45-degree field of view · image size 1932x1932
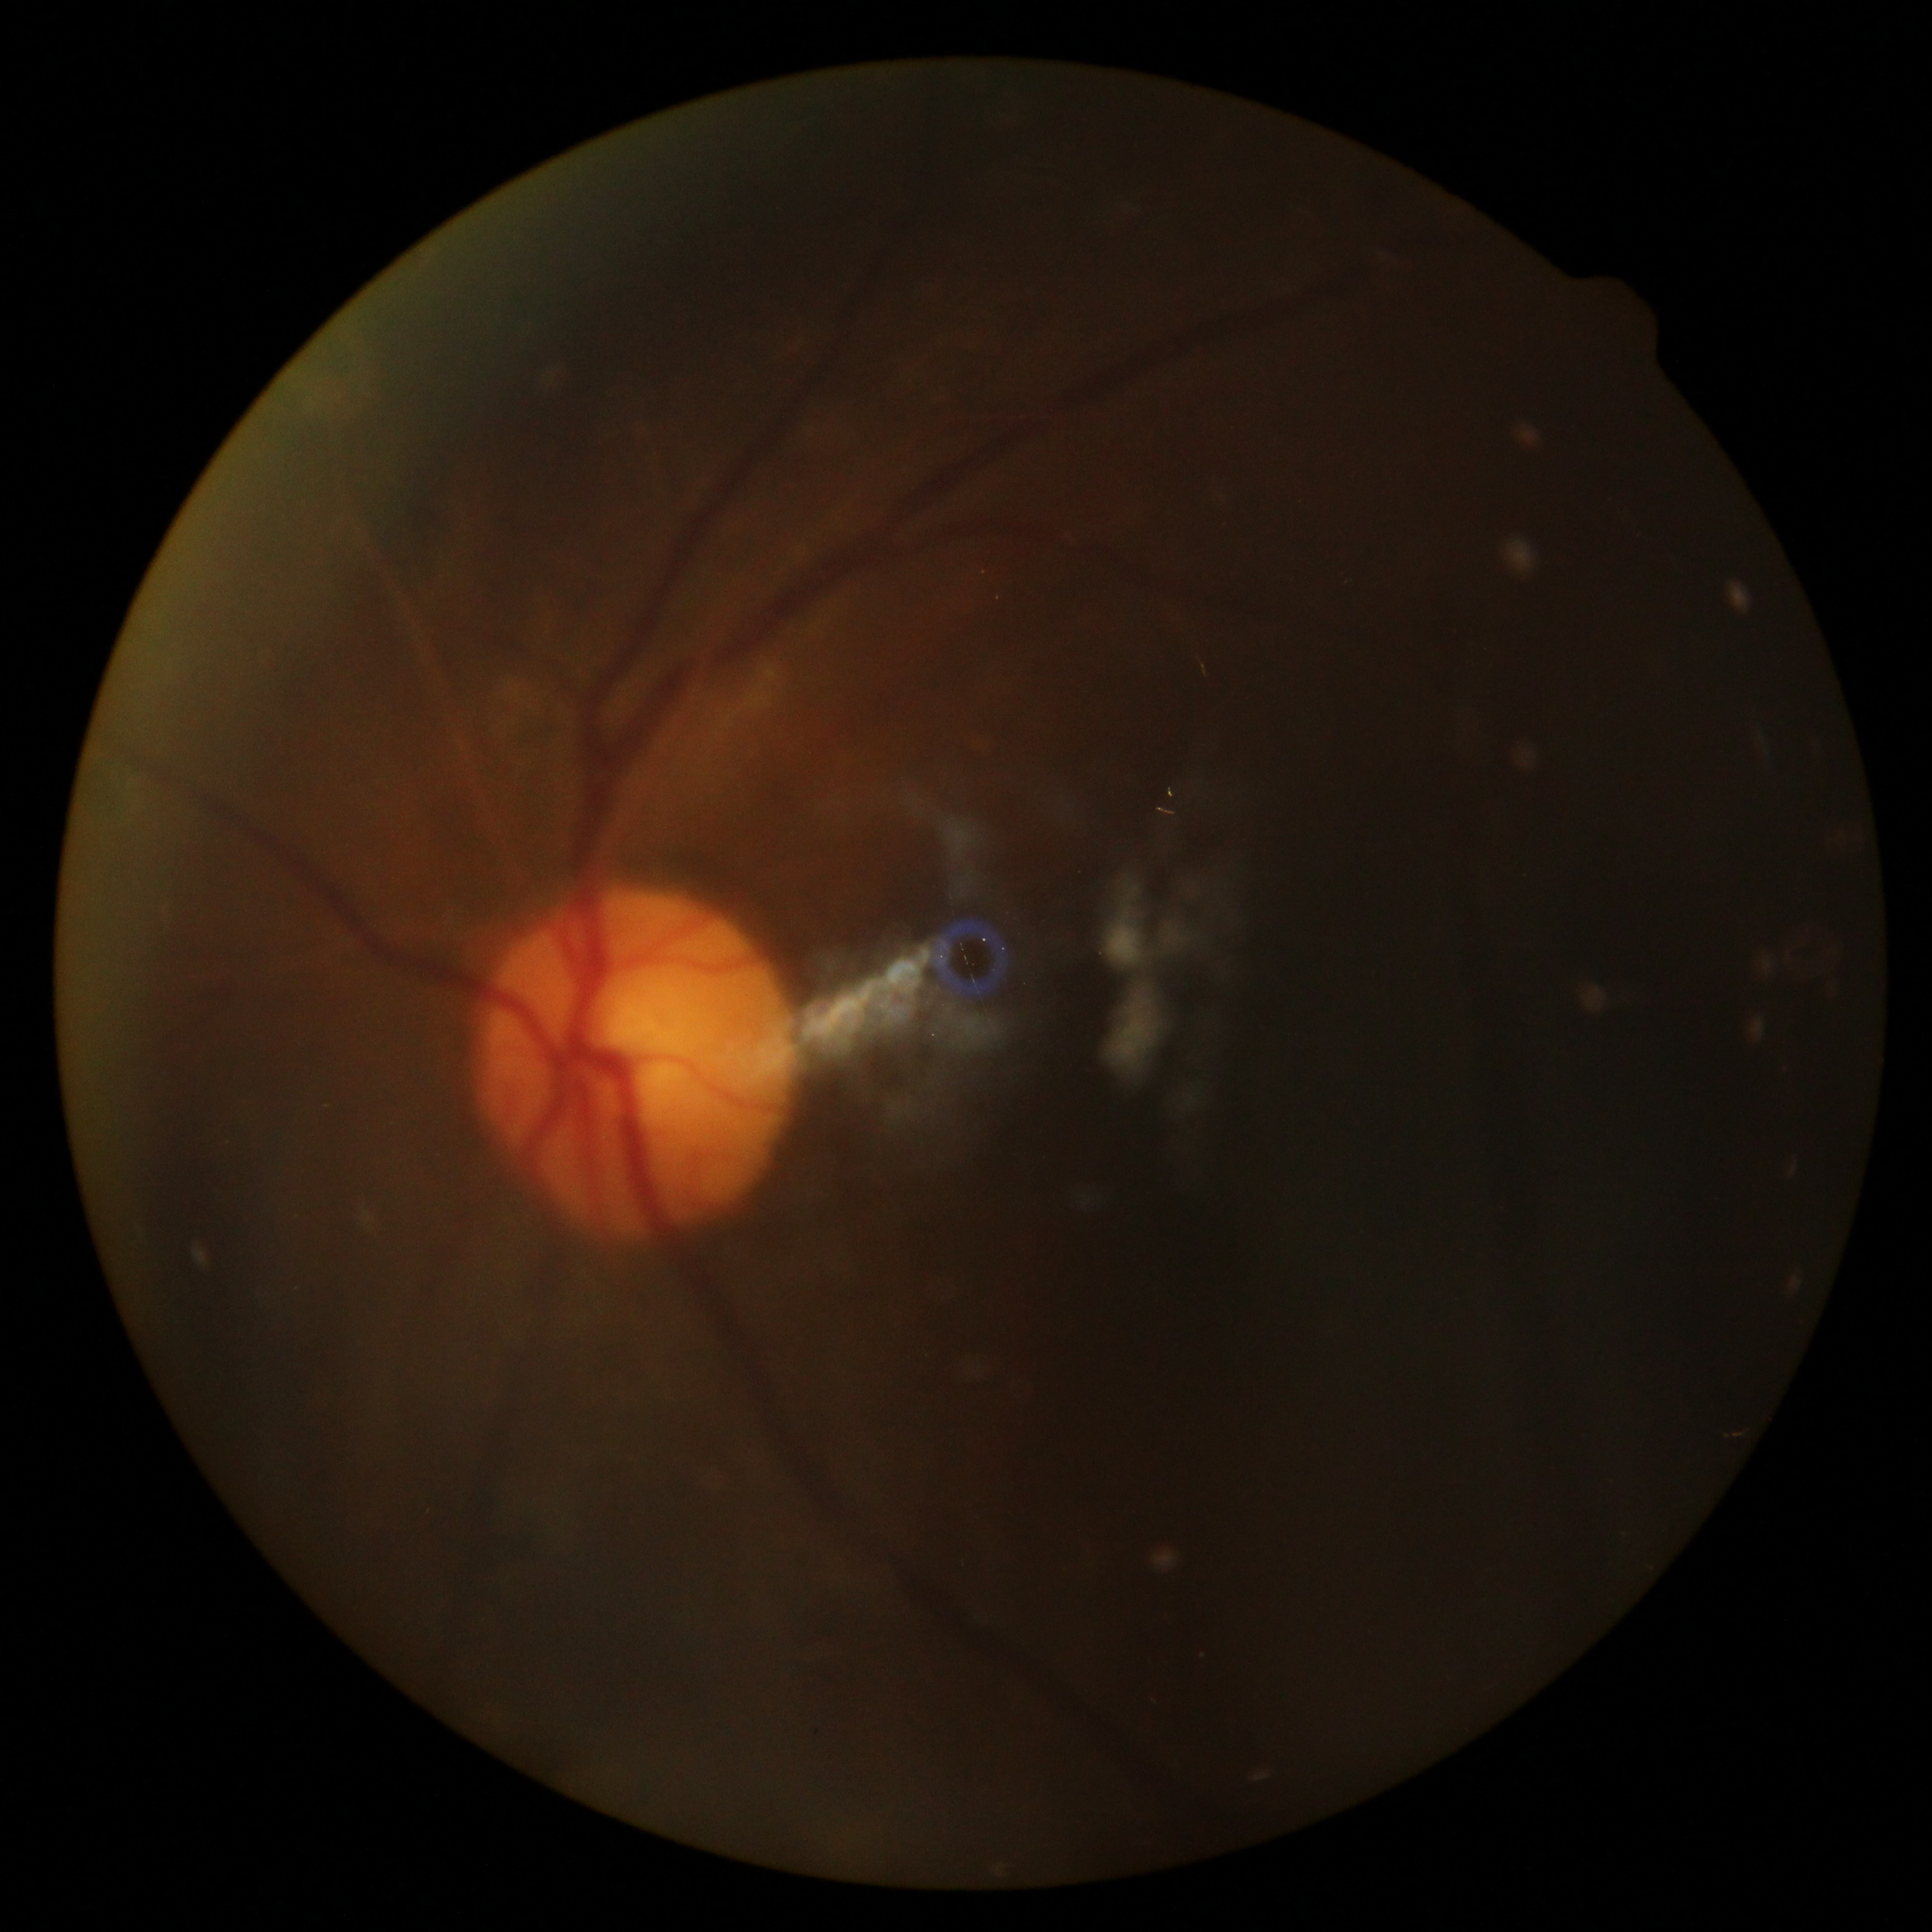

Diabetic retinopathy grade is ungradable. Image quality is insufficient for diabetic retinopathy assessment.